Phoenix ICON wide-field infant fundus image: 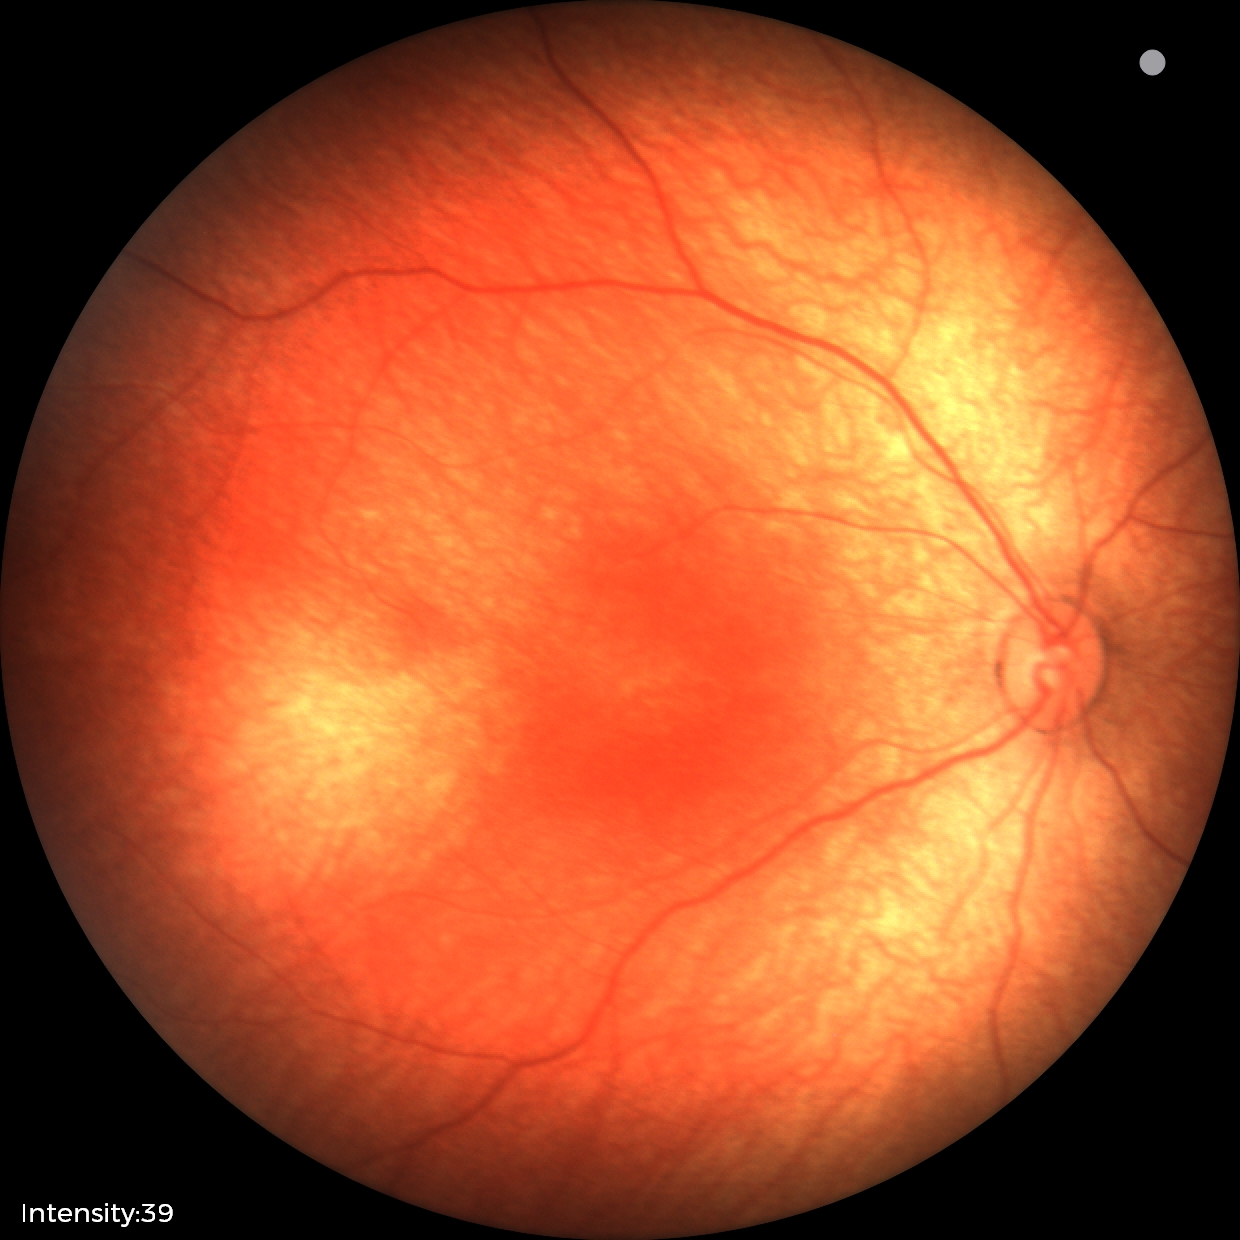
Physiological retinal appearance for postconceptual age.